2212x1659, color fundus photograph, FOV: 45 degrees — 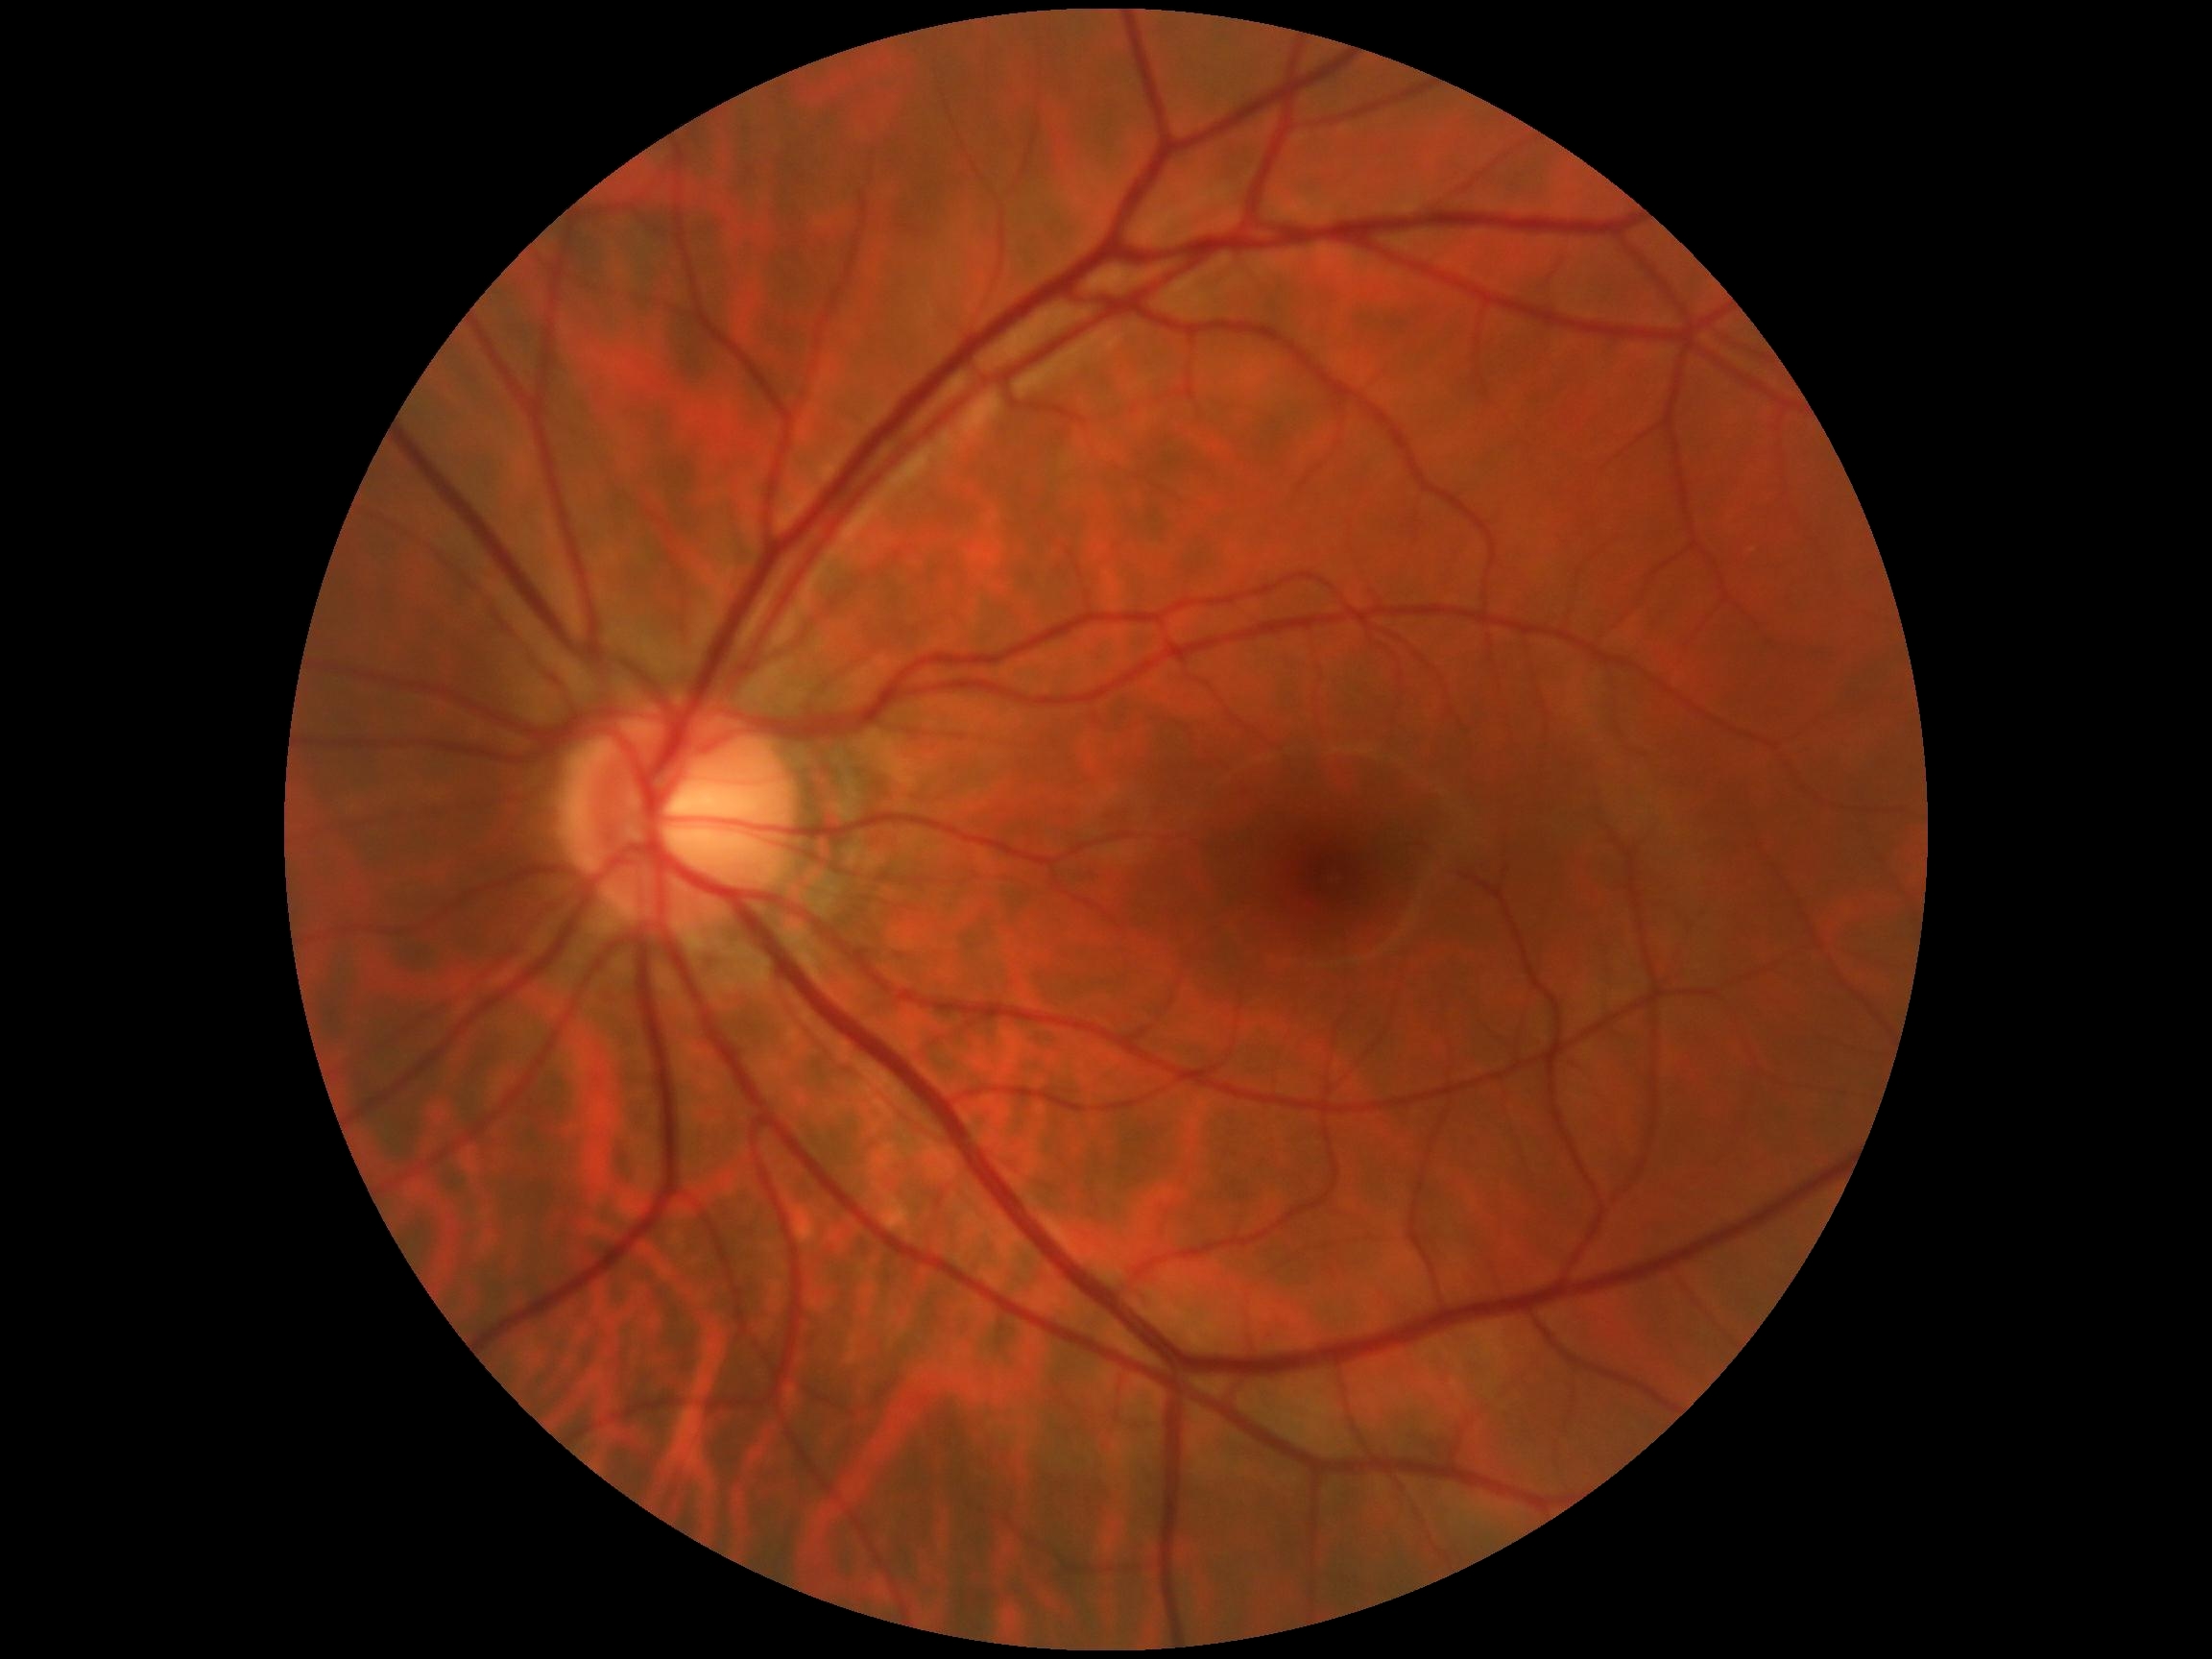

  dr_grade: grade 0